Optic disc photograph: 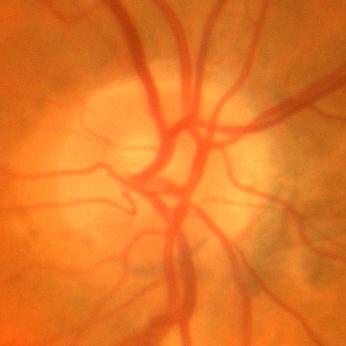
Glaucoma diagnosis: no glaucoma.